Pupil-dilated
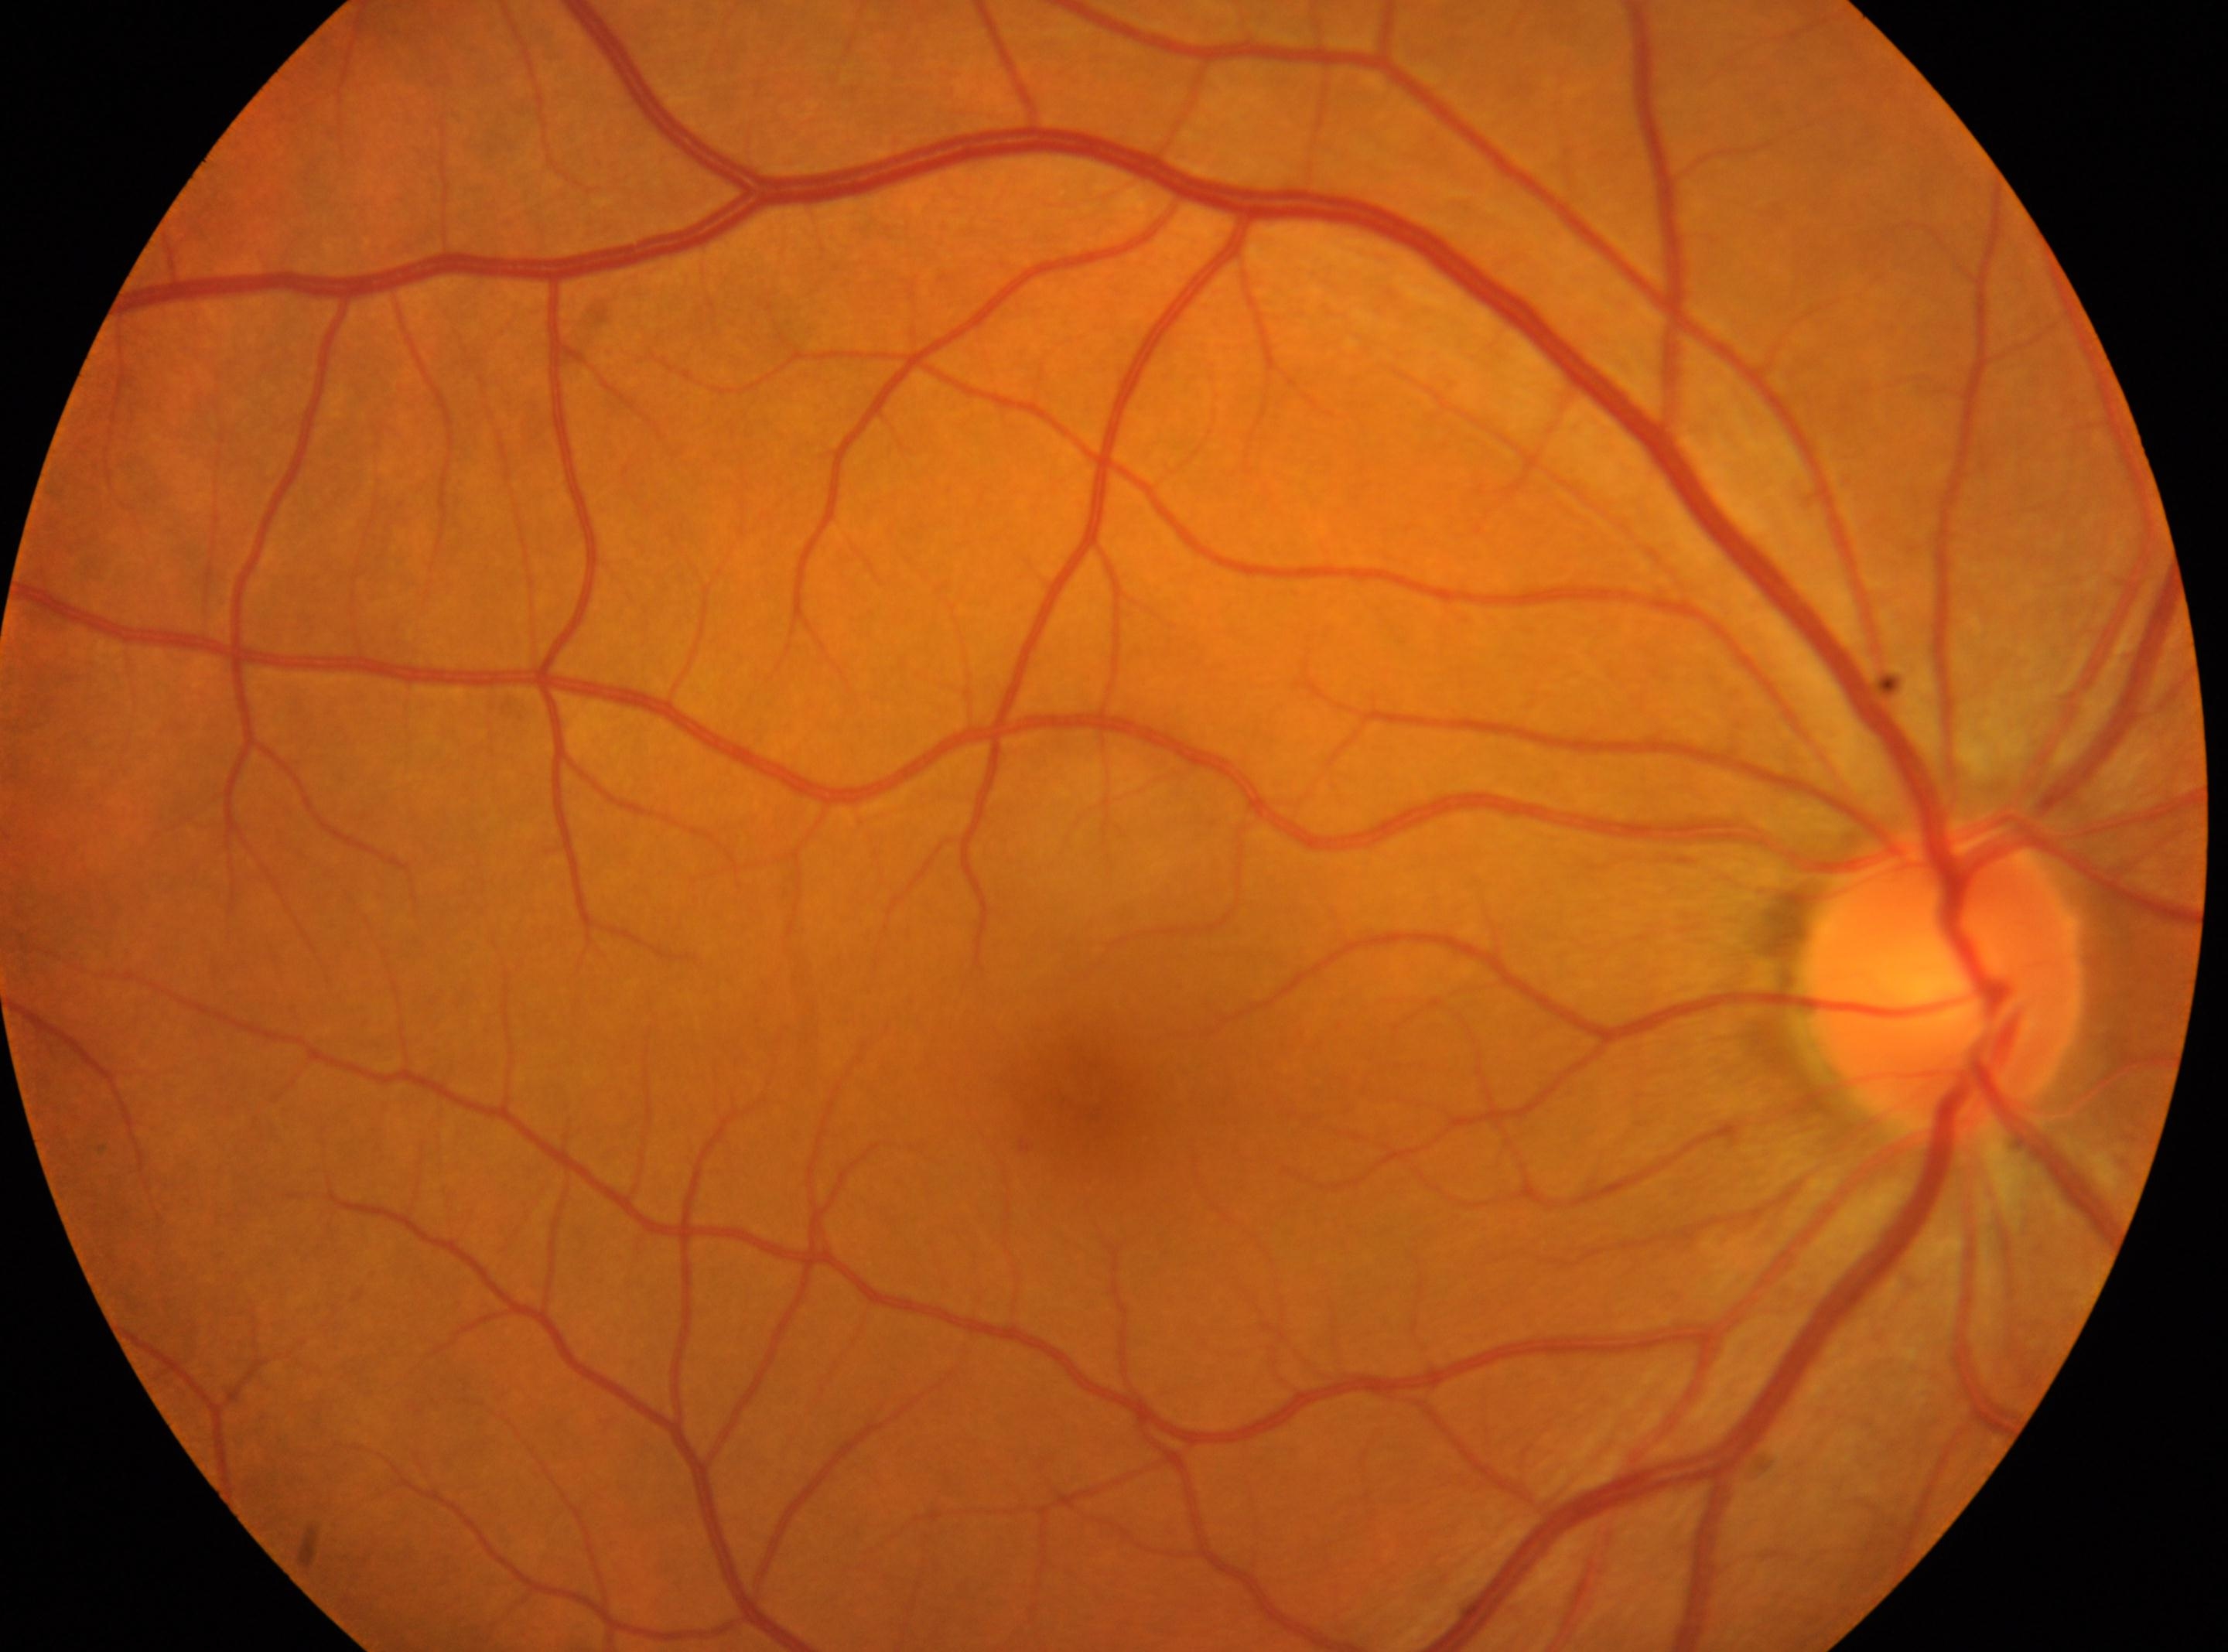 The optic nerve head is at 1943px, 973px. Diabetic retinopathy (DR) is grade 0. Macular center located at 1088px, 1108px. No diabetic retinopathy identified. Eye: OD.